50-degree field of view. Fundus photo.
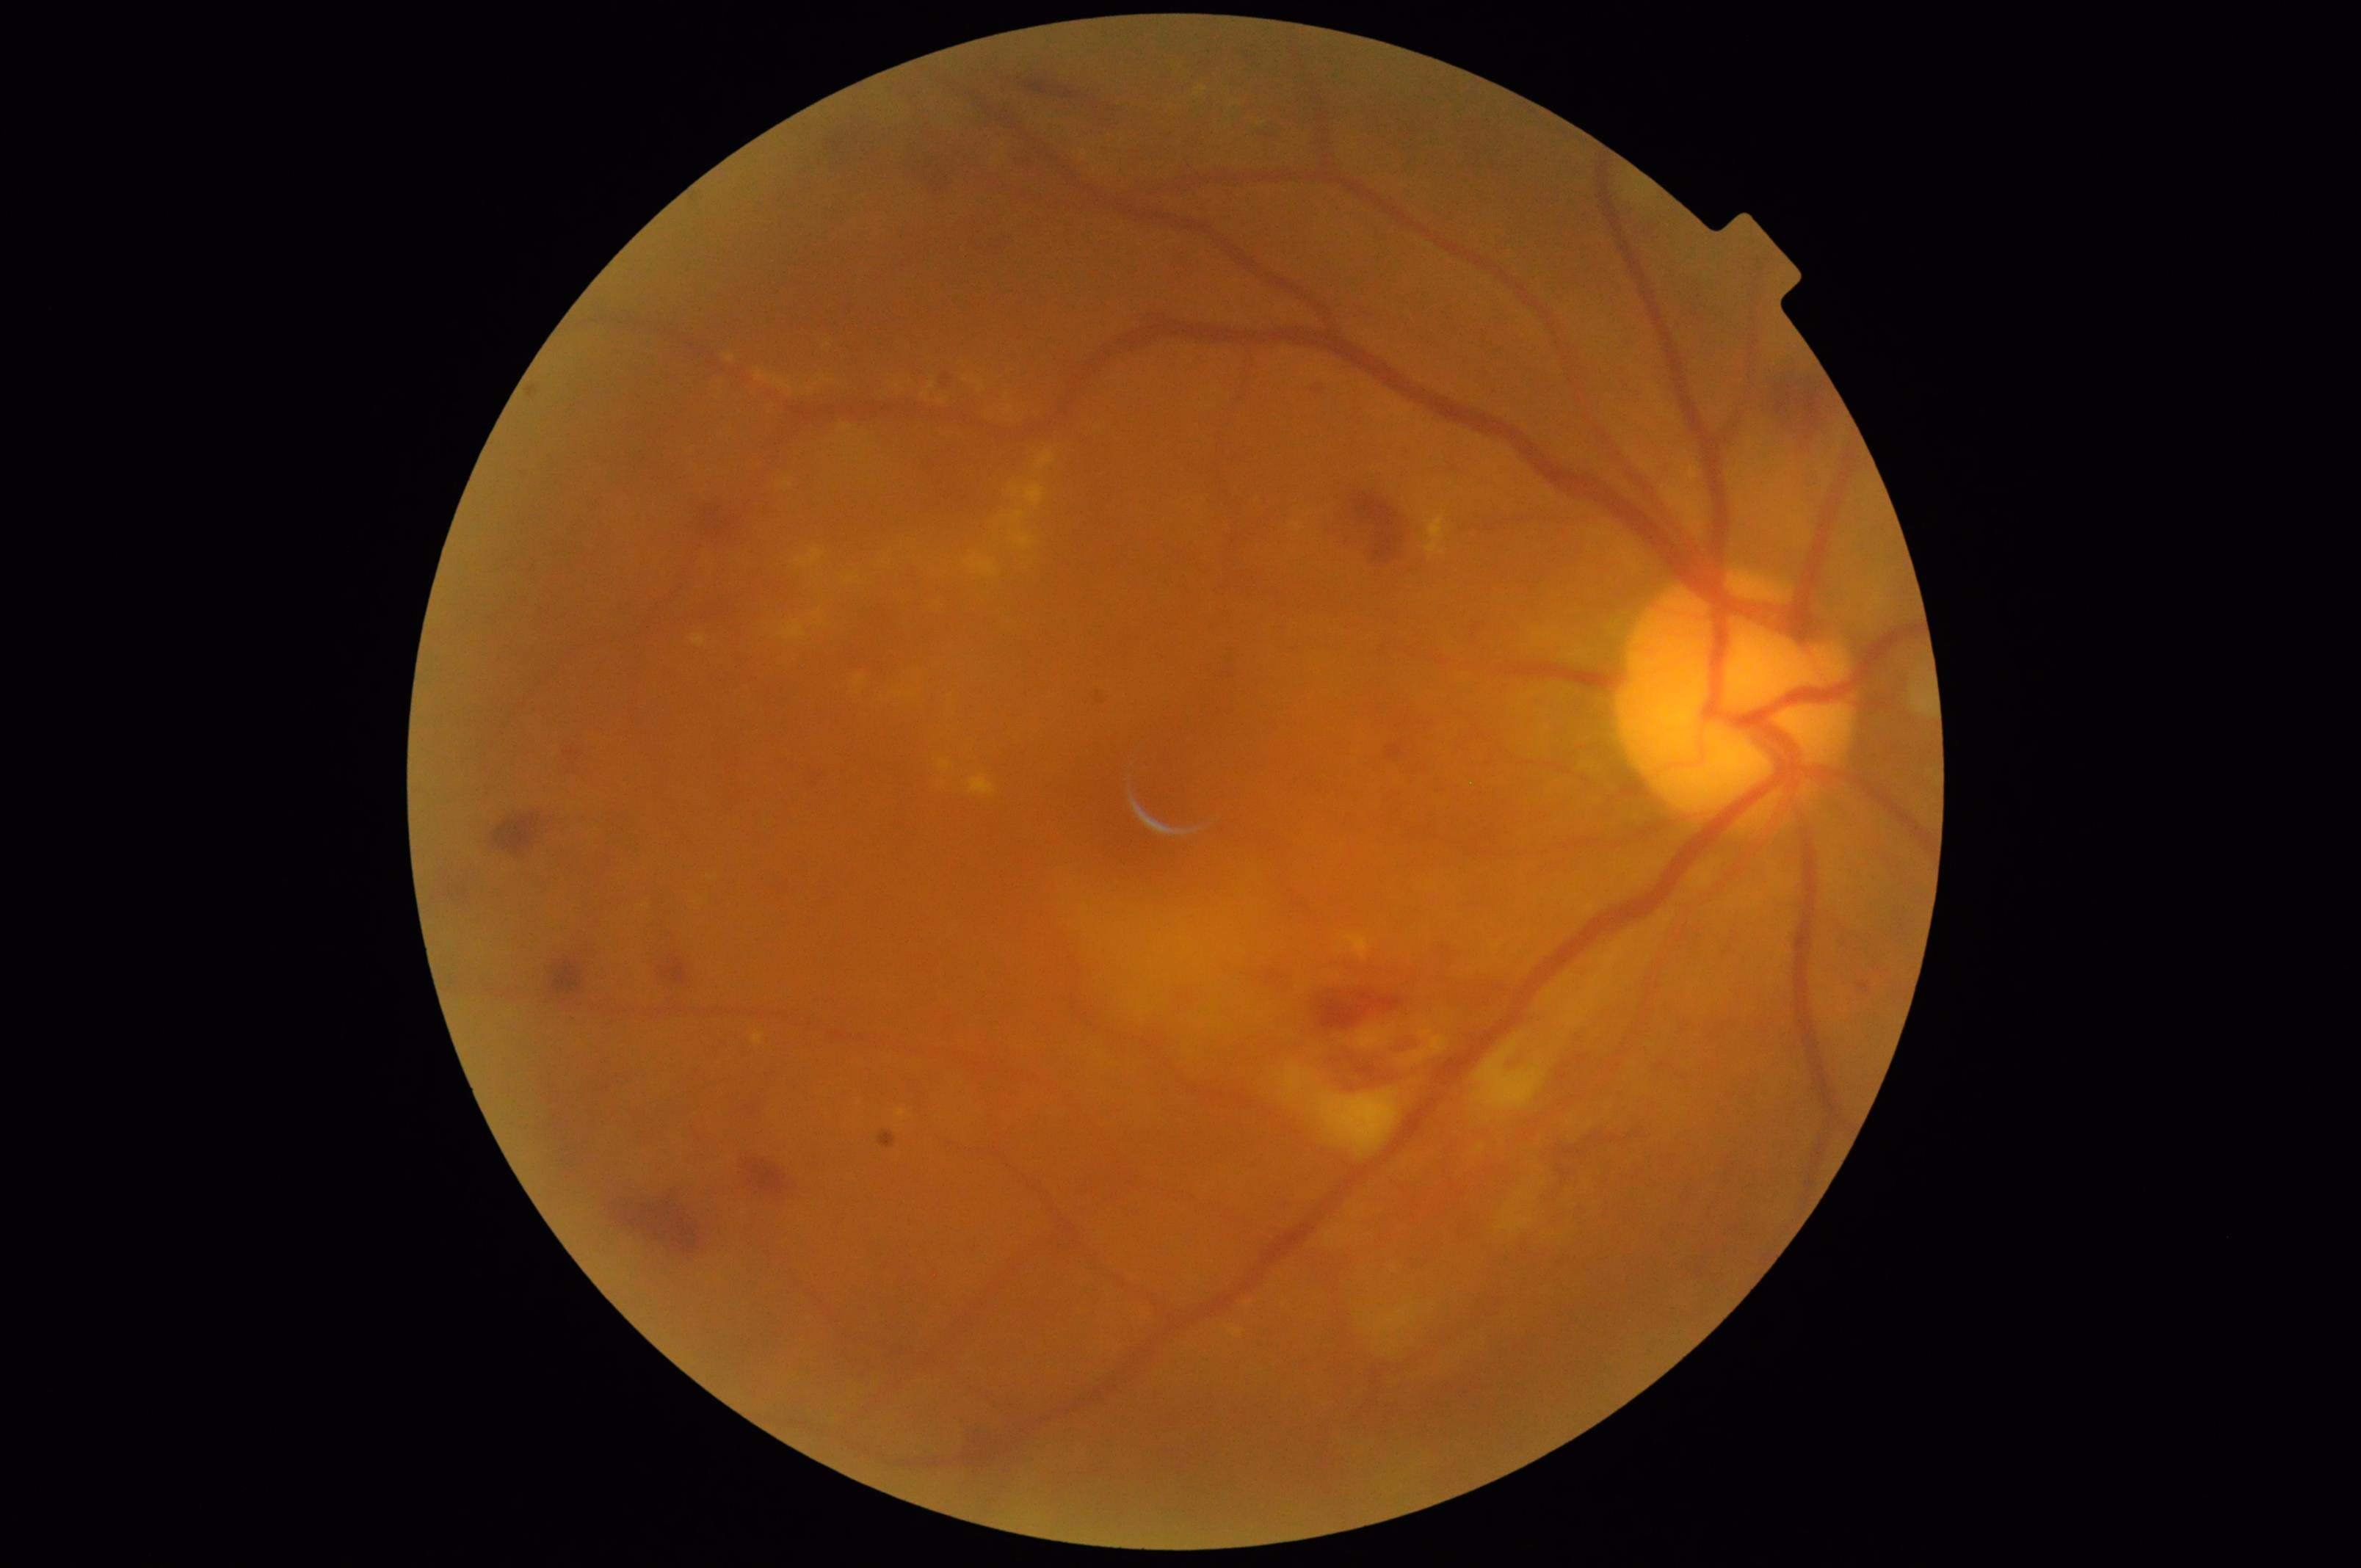
Contrast = good
Illumination/color = even
Overall = acceptable
Focus = out of focus